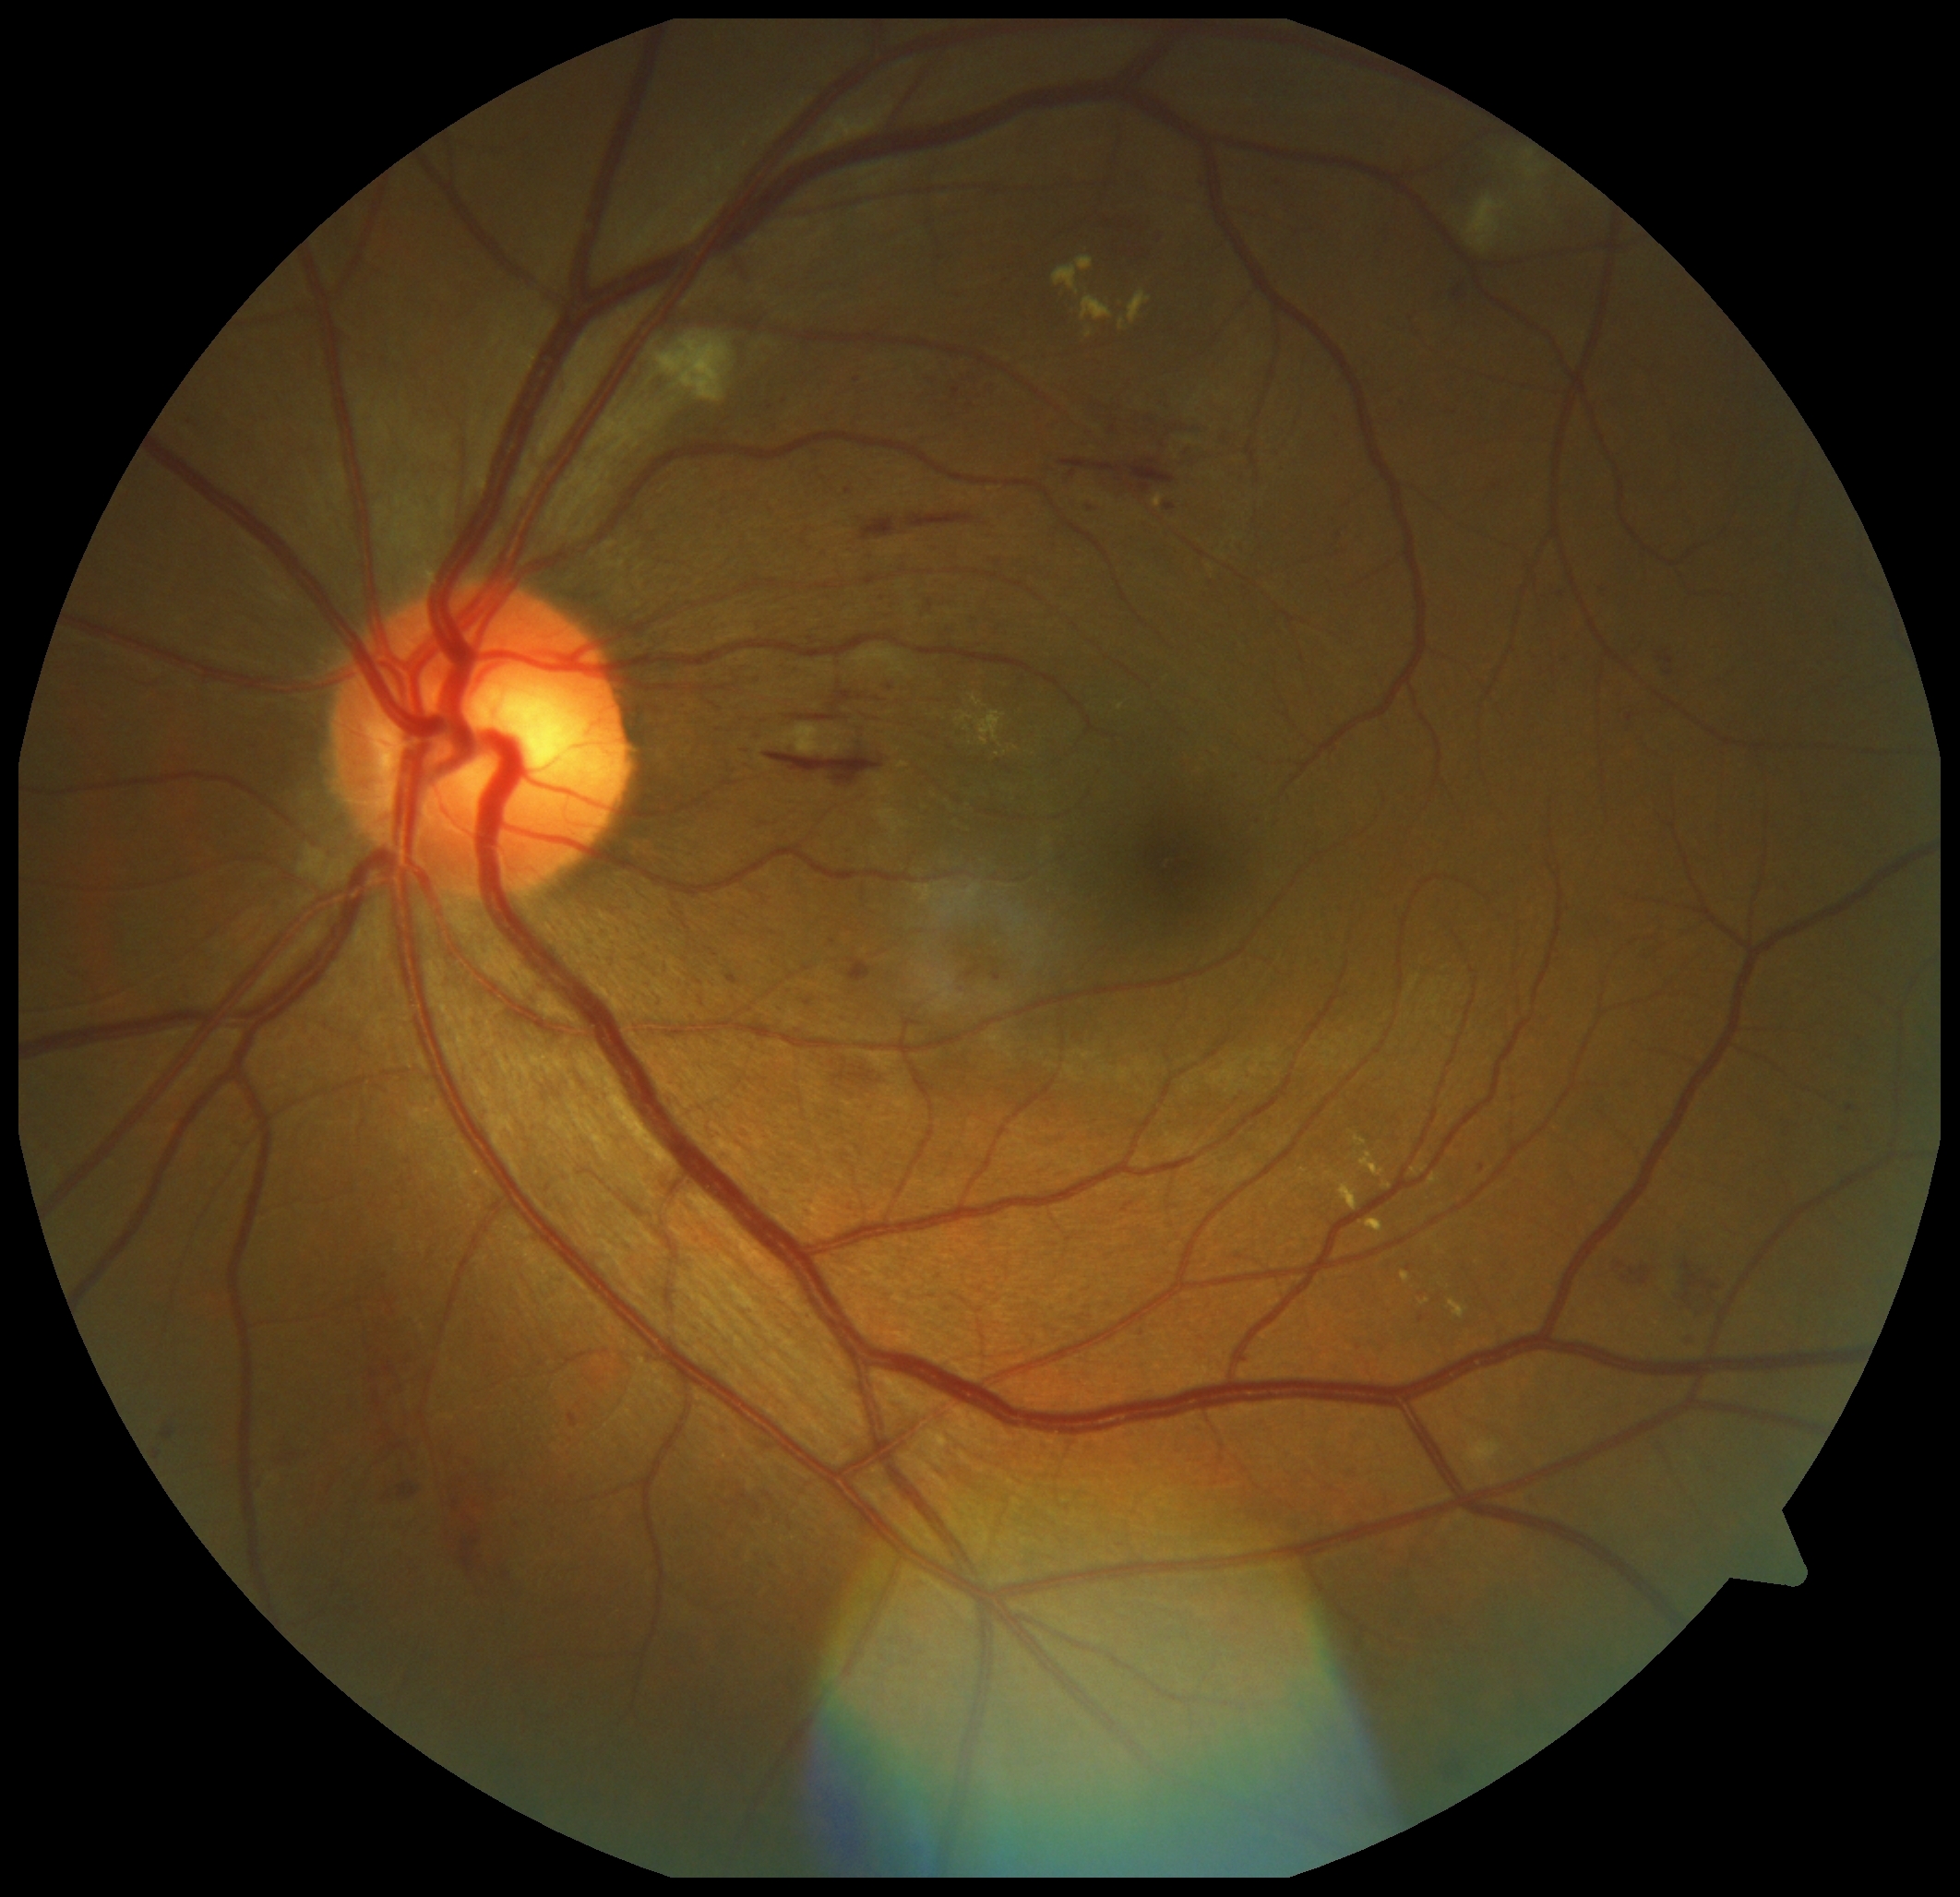 DR grade: 2. HEs (partial list) at x1=1667, y1=670, x2=1675, y2=676 | x1=1679, y1=1276, x2=1722, y2=1310 | x1=832, y1=1062, x2=876, y2=1087 | x1=290, y1=1452, x2=306, y2=1466 | x1=365, y1=1359, x2=397, y2=1466 | x1=914, y1=590, x2=928, y2=614 | x1=860, y1=519, x2=898, y2=541 | x1=765, y1=751, x2=885, y2=787 | x1=1059, y1=459, x2=1125, y2=479 | x1=459, y1=1492, x2=491, y2=1579 | x1=847, y1=960, x2=873, y2=984 | x1=1666, y1=657, x2=1675, y2=664 | x1=393, y1=1334, x2=419, y2=1396 | x1=1112, y1=410, x2=1190, y2=437 | x1=1127, y1=459, x2=1176, y2=494 | x1=399, y1=1483, x2=417, y2=1497 | x1=1620, y1=1263, x2=1655, y2=1285 | x1=903, y1=513, x2=976, y2=528. HEs (small, approximate centers) near 480, 1584. EXs (partial list) at x1=1153, y1=494, x2=1165, y2=507 | x1=1129, y1=292, x2=1153, y2=323 | x1=1450, y1=1299, x2=1468, y2=1319 | x1=1356, y1=1138, x2=1368, y2=1147 | x1=1361, y1=1152, x2=1386, y2=1177 | x1=1412, y1=1165, x2=1428, y2=1177 | x1=1054, y1=257, x2=1095, y2=295 | x1=973, y1=697, x2=980, y2=706 | x1=1384, y1=1185, x2=1392, y2=1190 | x1=1085, y1=328, x2=1094, y2=339. EXs (small, approximate centers) near 967, 729. MAs (partial list) at x1=1455, y1=290, x2=1463, y2=299 | x1=845, y1=488, x2=853, y2=495 | x1=153, y1=1450, x2=161, y2=1461 | x1=1257, y1=817, x2=1270, y2=822 | x1=990, y1=972, x2=999, y2=984 | x1=1526, y1=1499, x2=1540, y2=1510 | x1=162, y1=1428, x2=173, y2=1439 | x1=727, y1=974, x2=740, y2=985. MAs (small, approximate centers) near 1423, 1319 | 1091, 510 | 1561, 595 | 1630, 718. SEs are located at x1=1512, y1=147, x2=1546, y2=196 | x1=648, y1=330, x2=735, y2=404 | x1=1466, y1=196, x2=1508, y2=252 | x1=780, y1=724, x2=825, y2=755.